DR severity per modified Davis staging, 848x848px
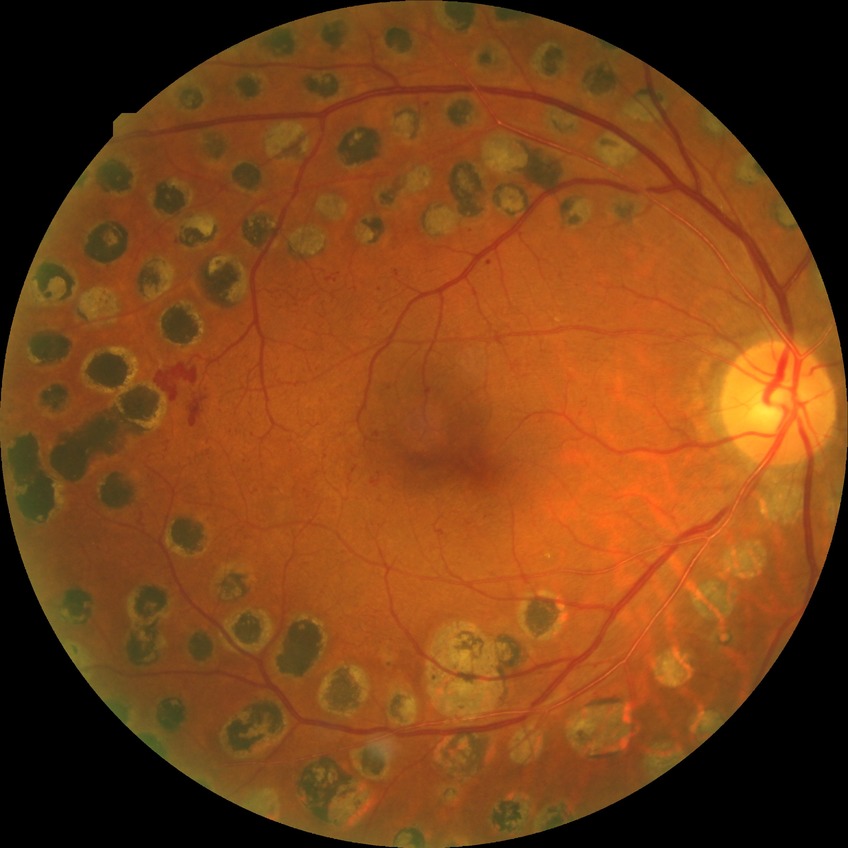
retinopathy grade: proliferative diabetic retinopathy.